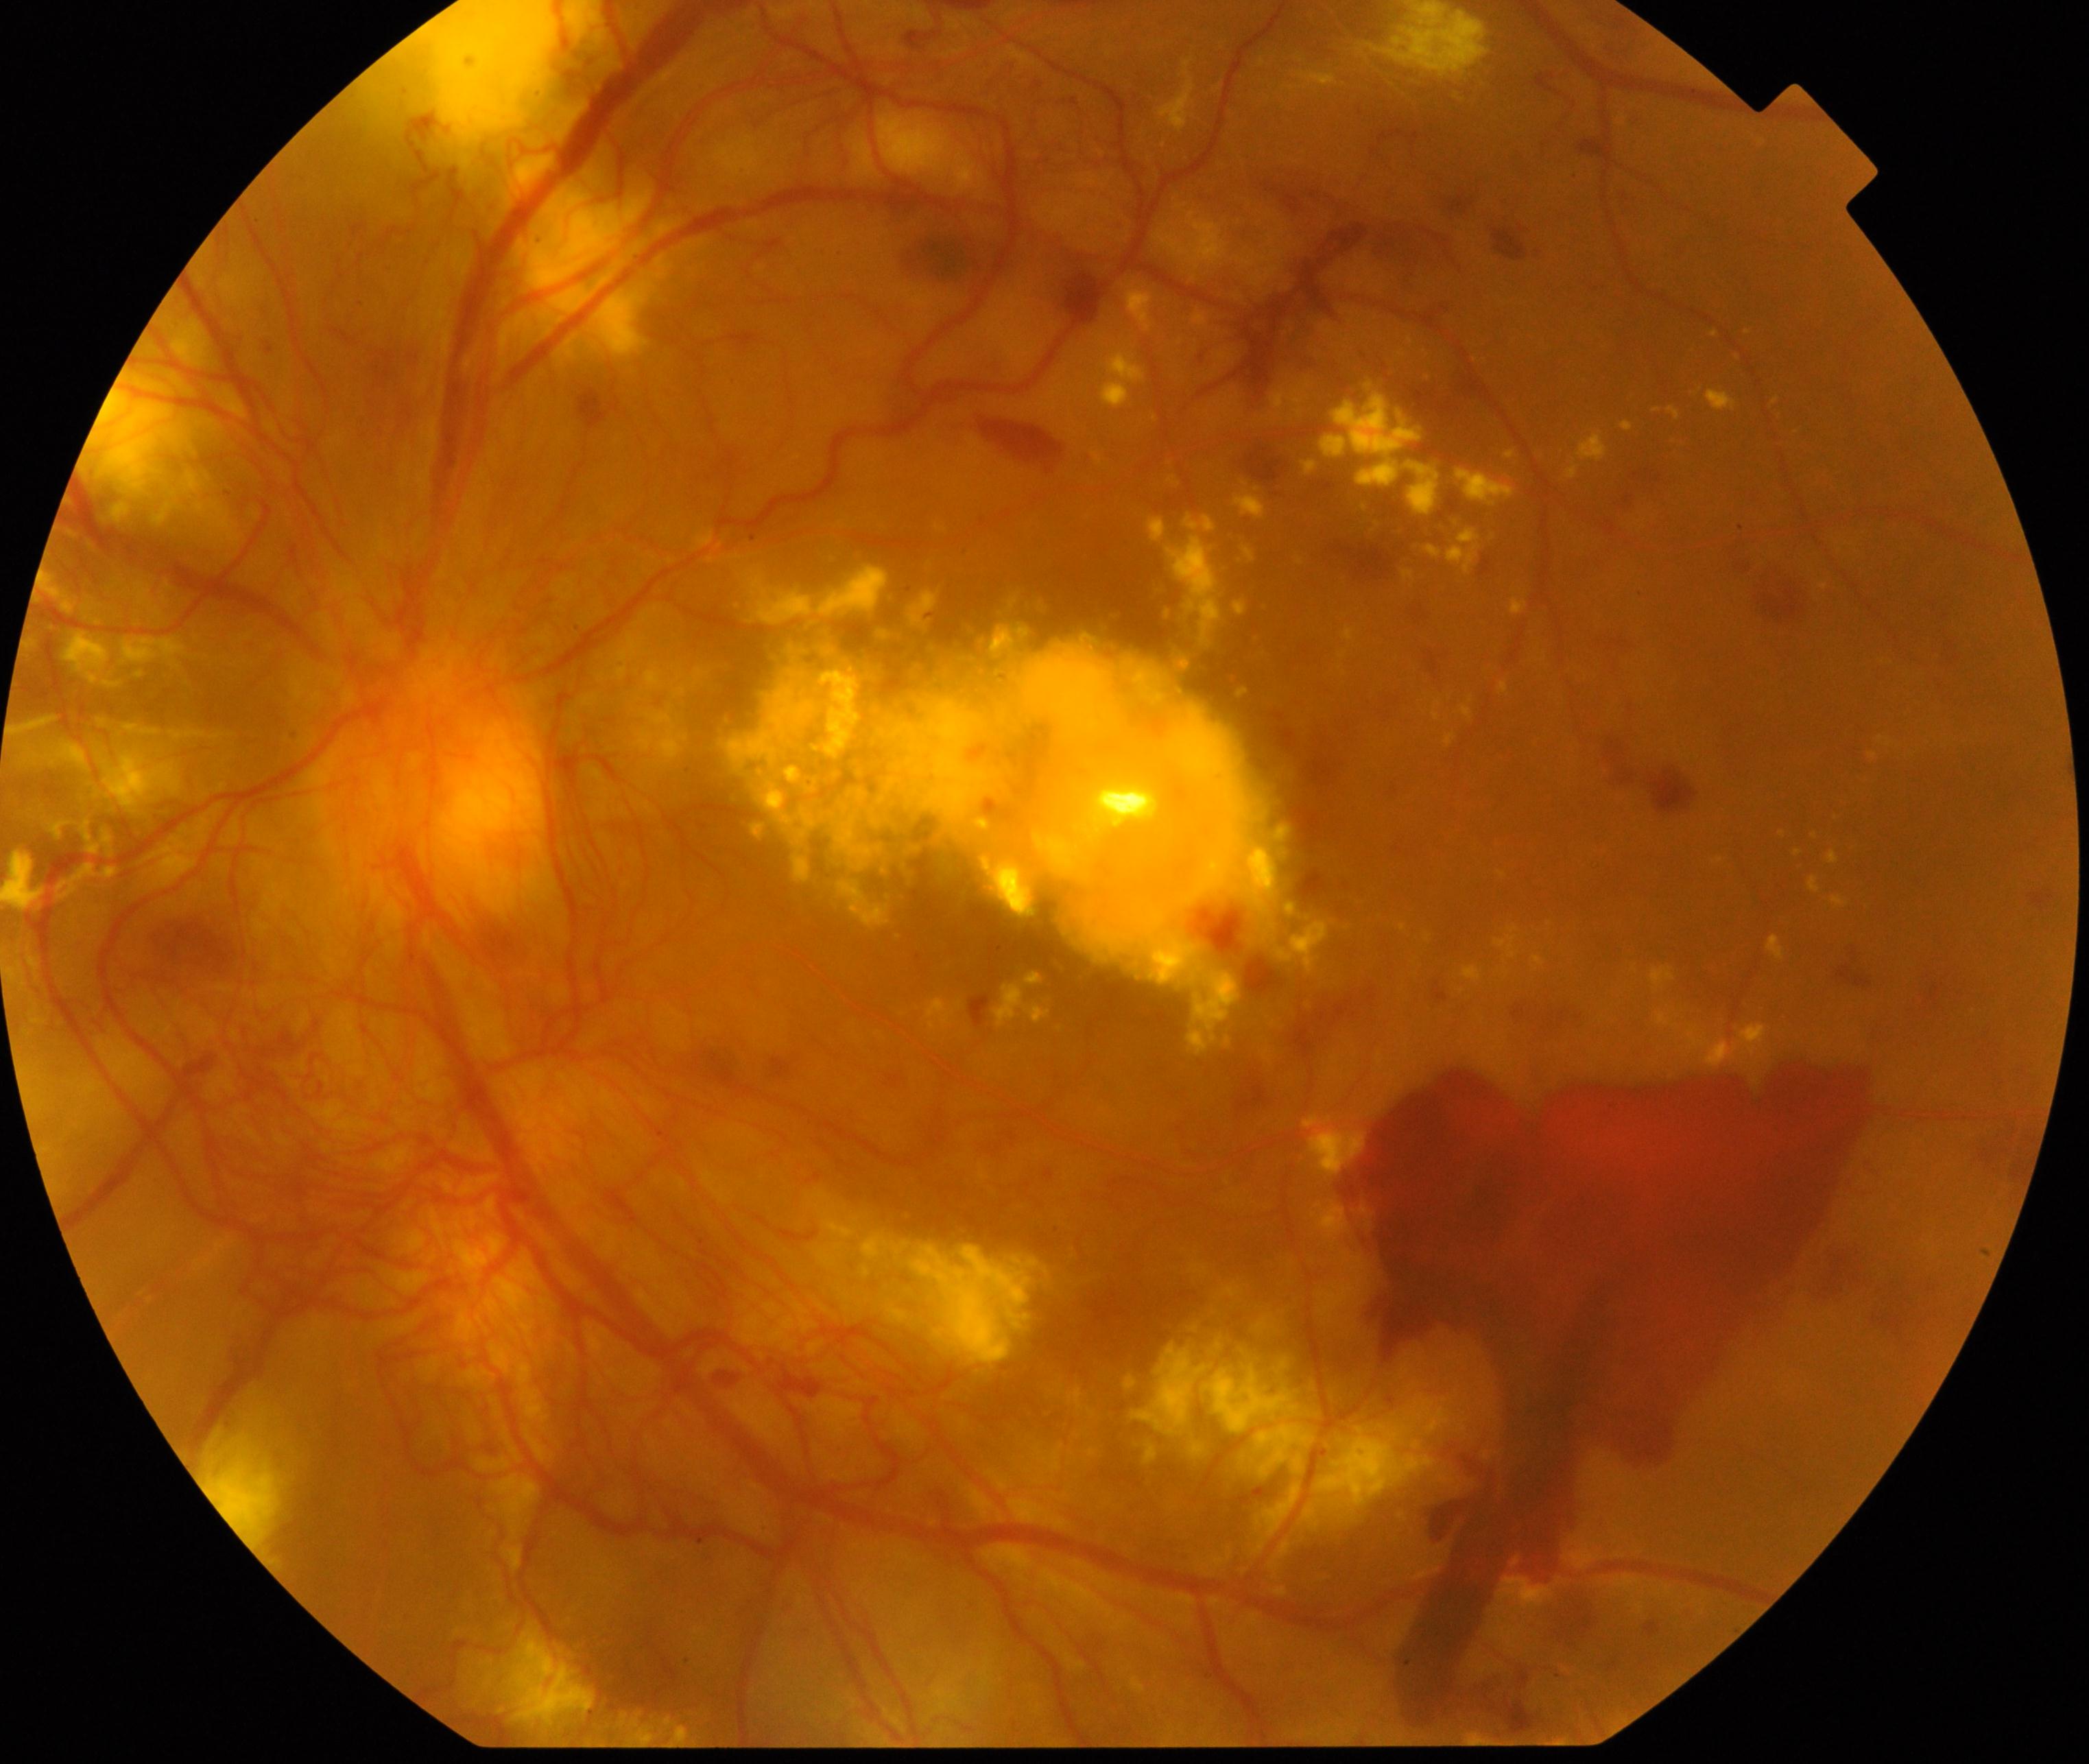 Classification: severe non-proliferative or proliferative diabetic retinopathy.